Color fundus image — 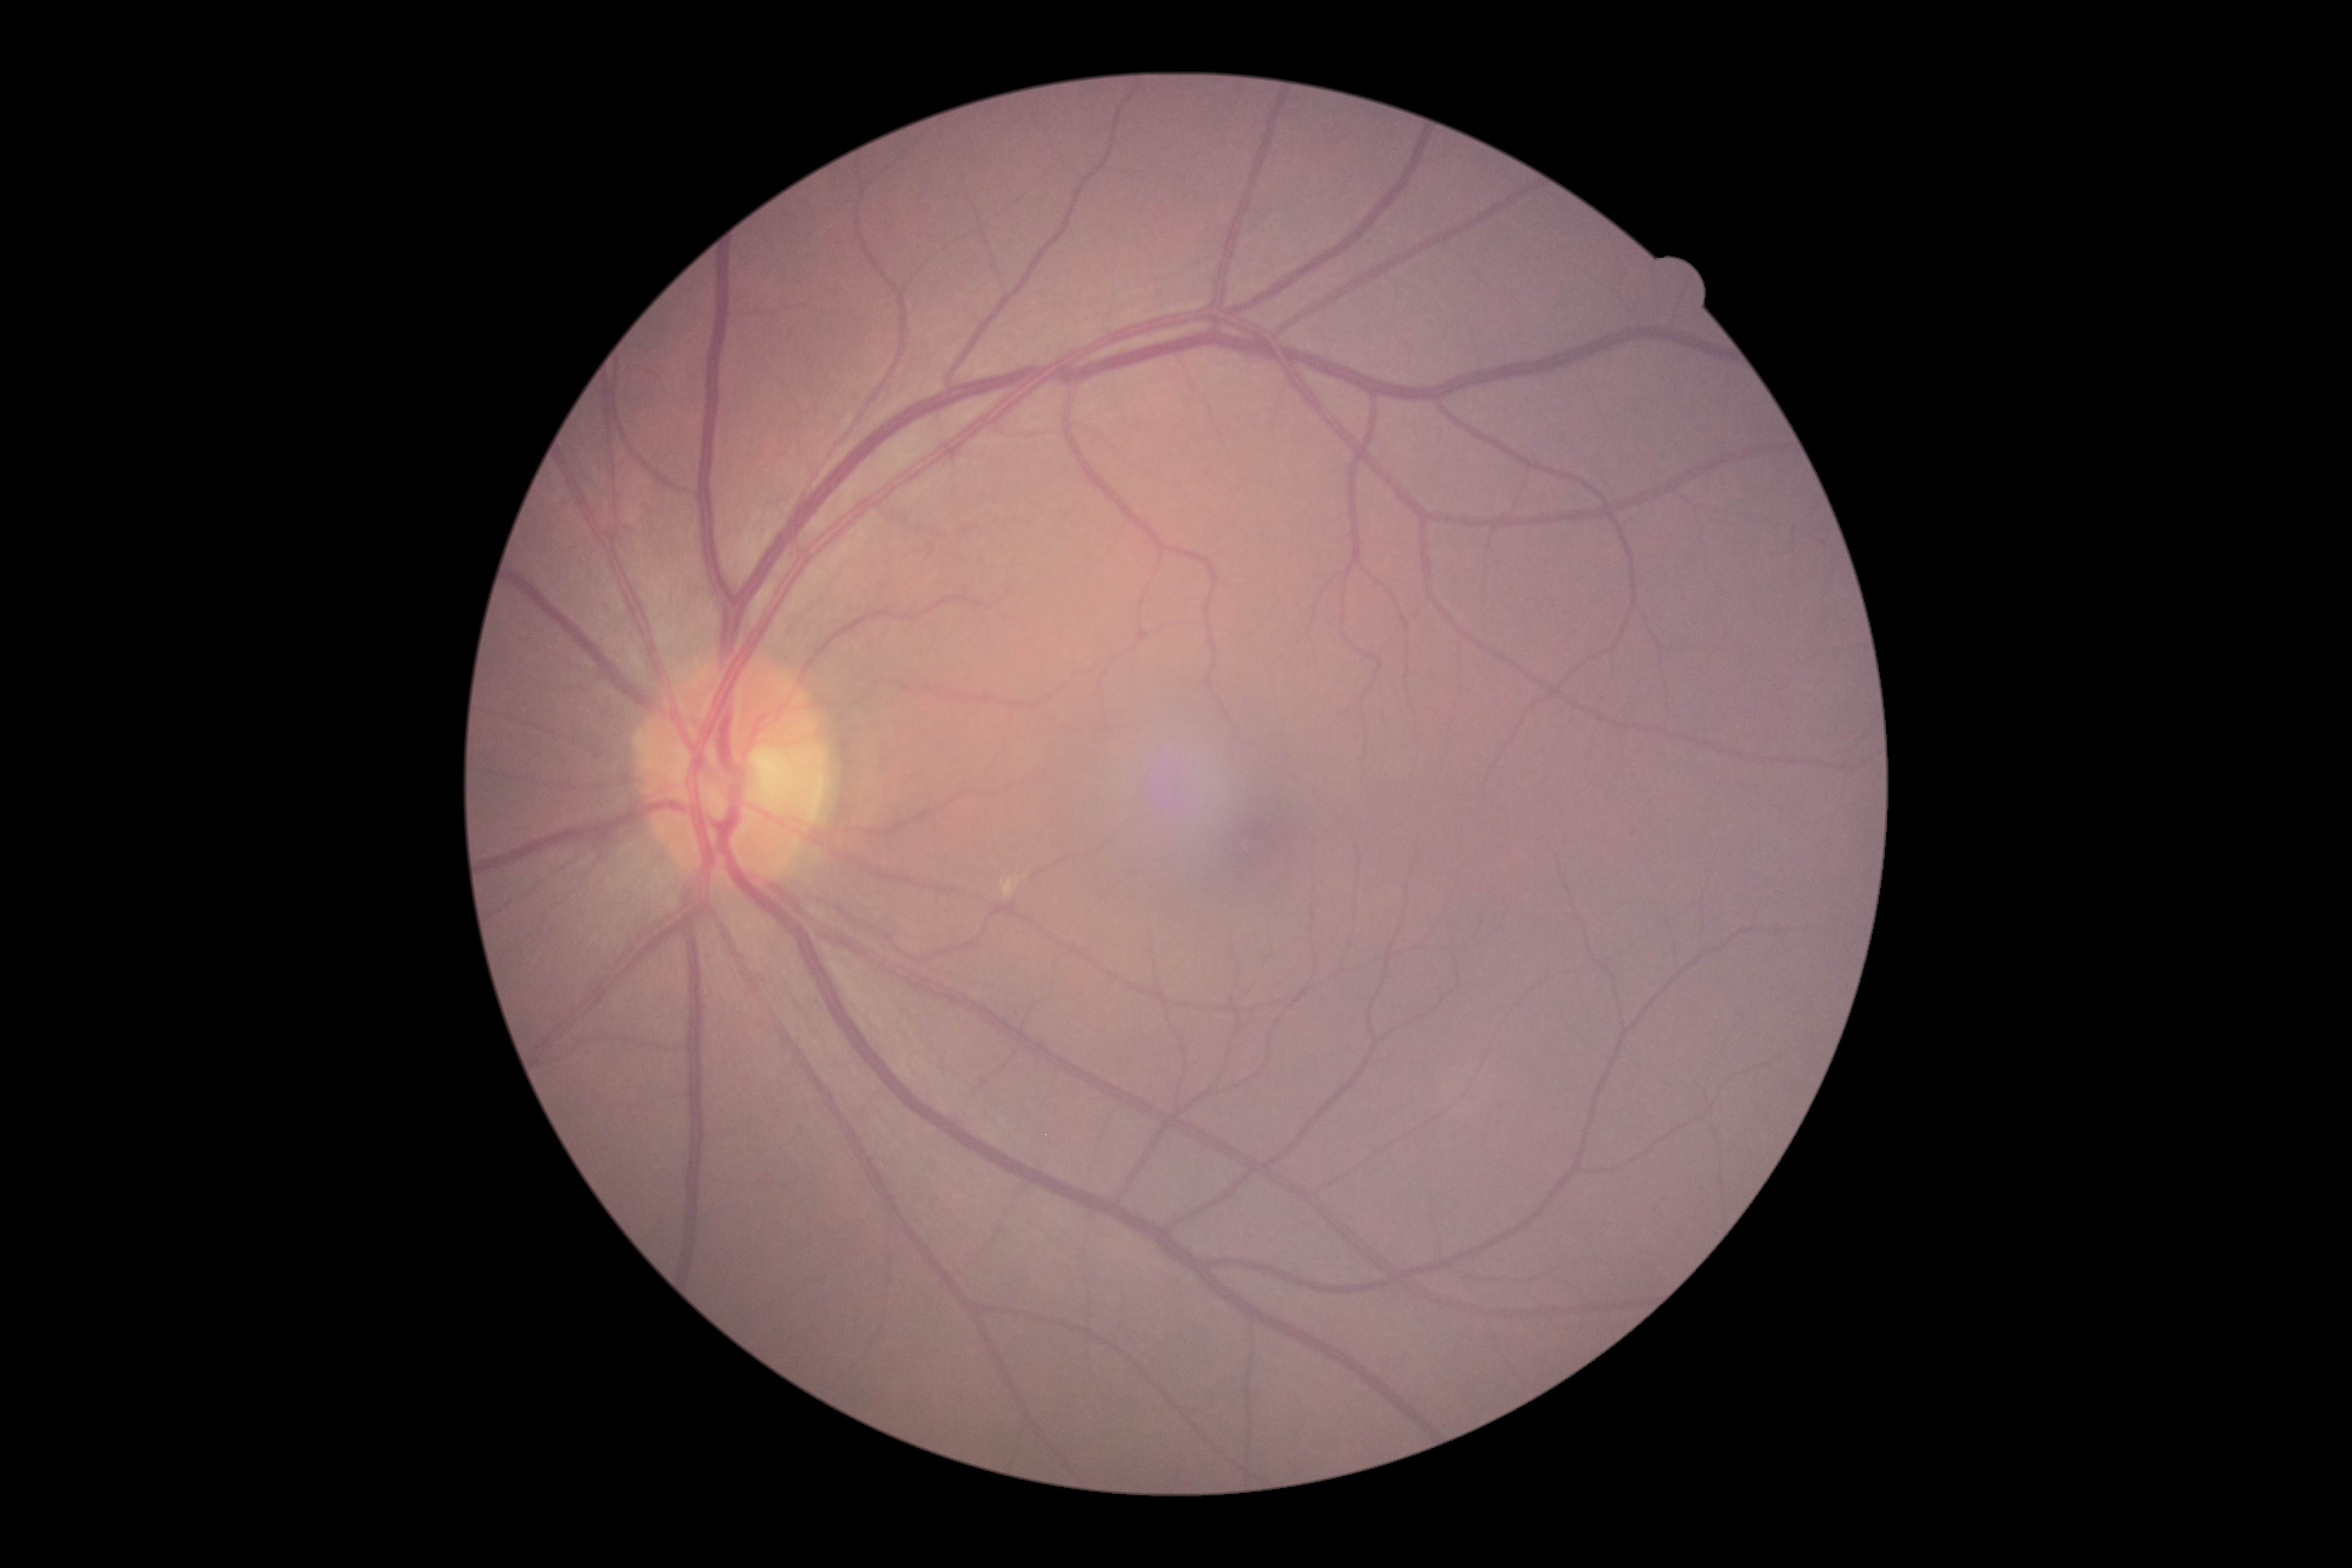

Diabetic retinopathy (DR): 0.
No diabetic retinal disease findings.